Diabetic retinopathy graded by the modified Davis classification. Image size 848x848:
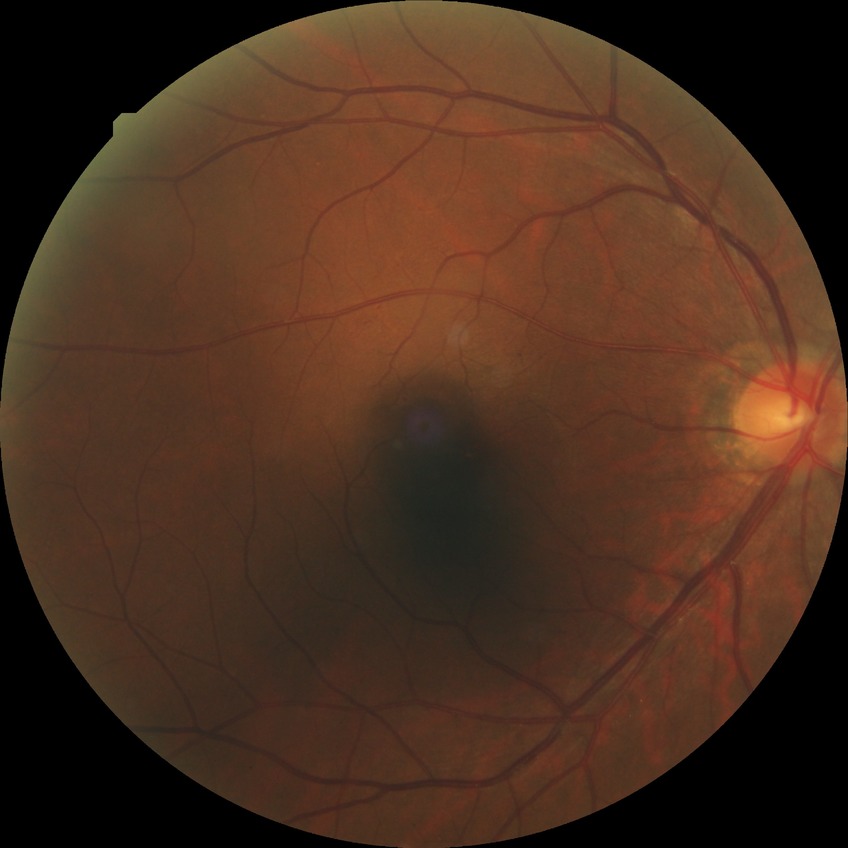

Modified Davis grading: simple diabetic retinopathy. Disease class: non-proliferative diabetic retinopathy.